Color fundus photograph · 848 x 848 pixels · 45° FOV
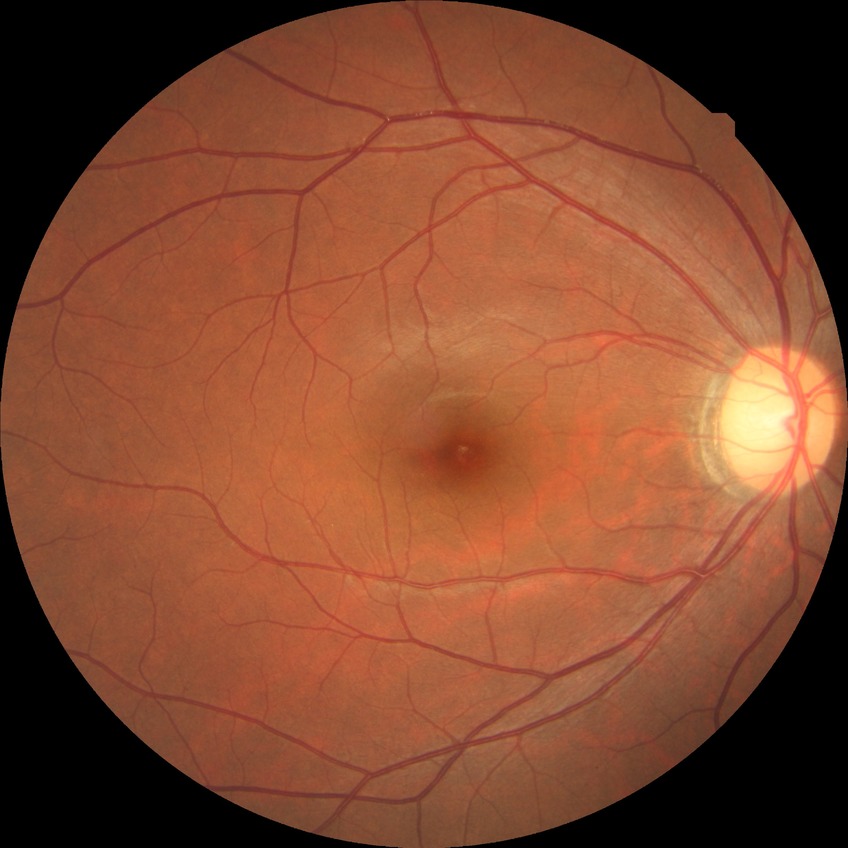

diabetic retinopathy (DR): NDR (no diabetic retinopathy).